Wide-field fundus image from infant ROP screening · 1240x1240 — 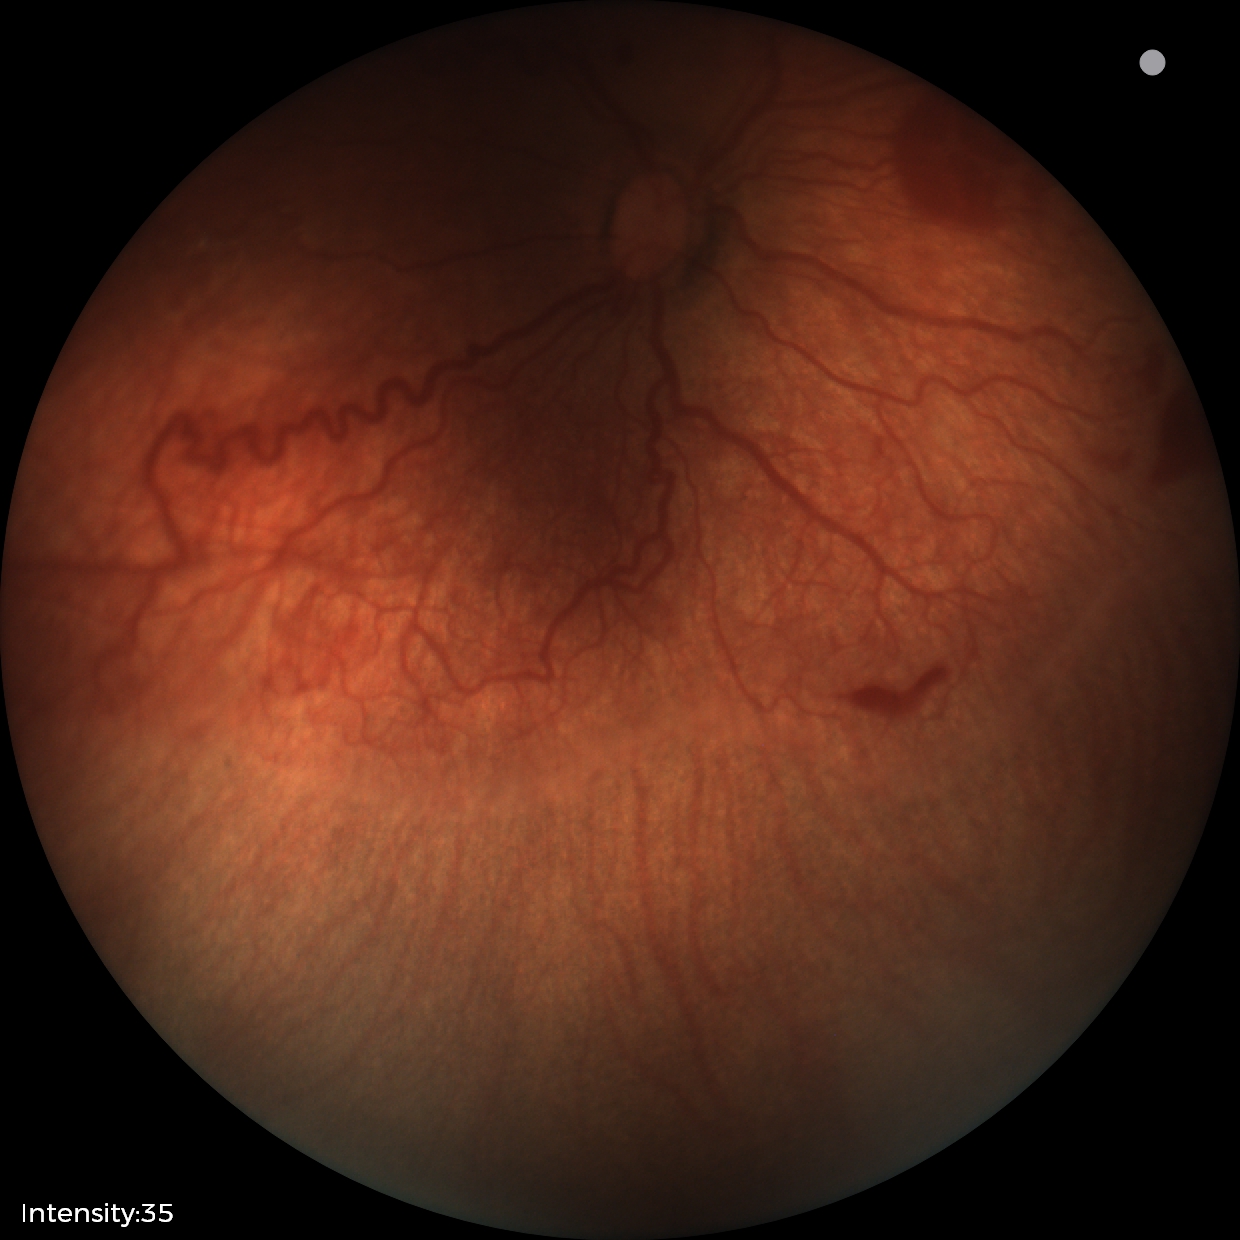
Examination diagnosed as retinopathy of prematurity stage 2.
With plus disease.